1920x1440: 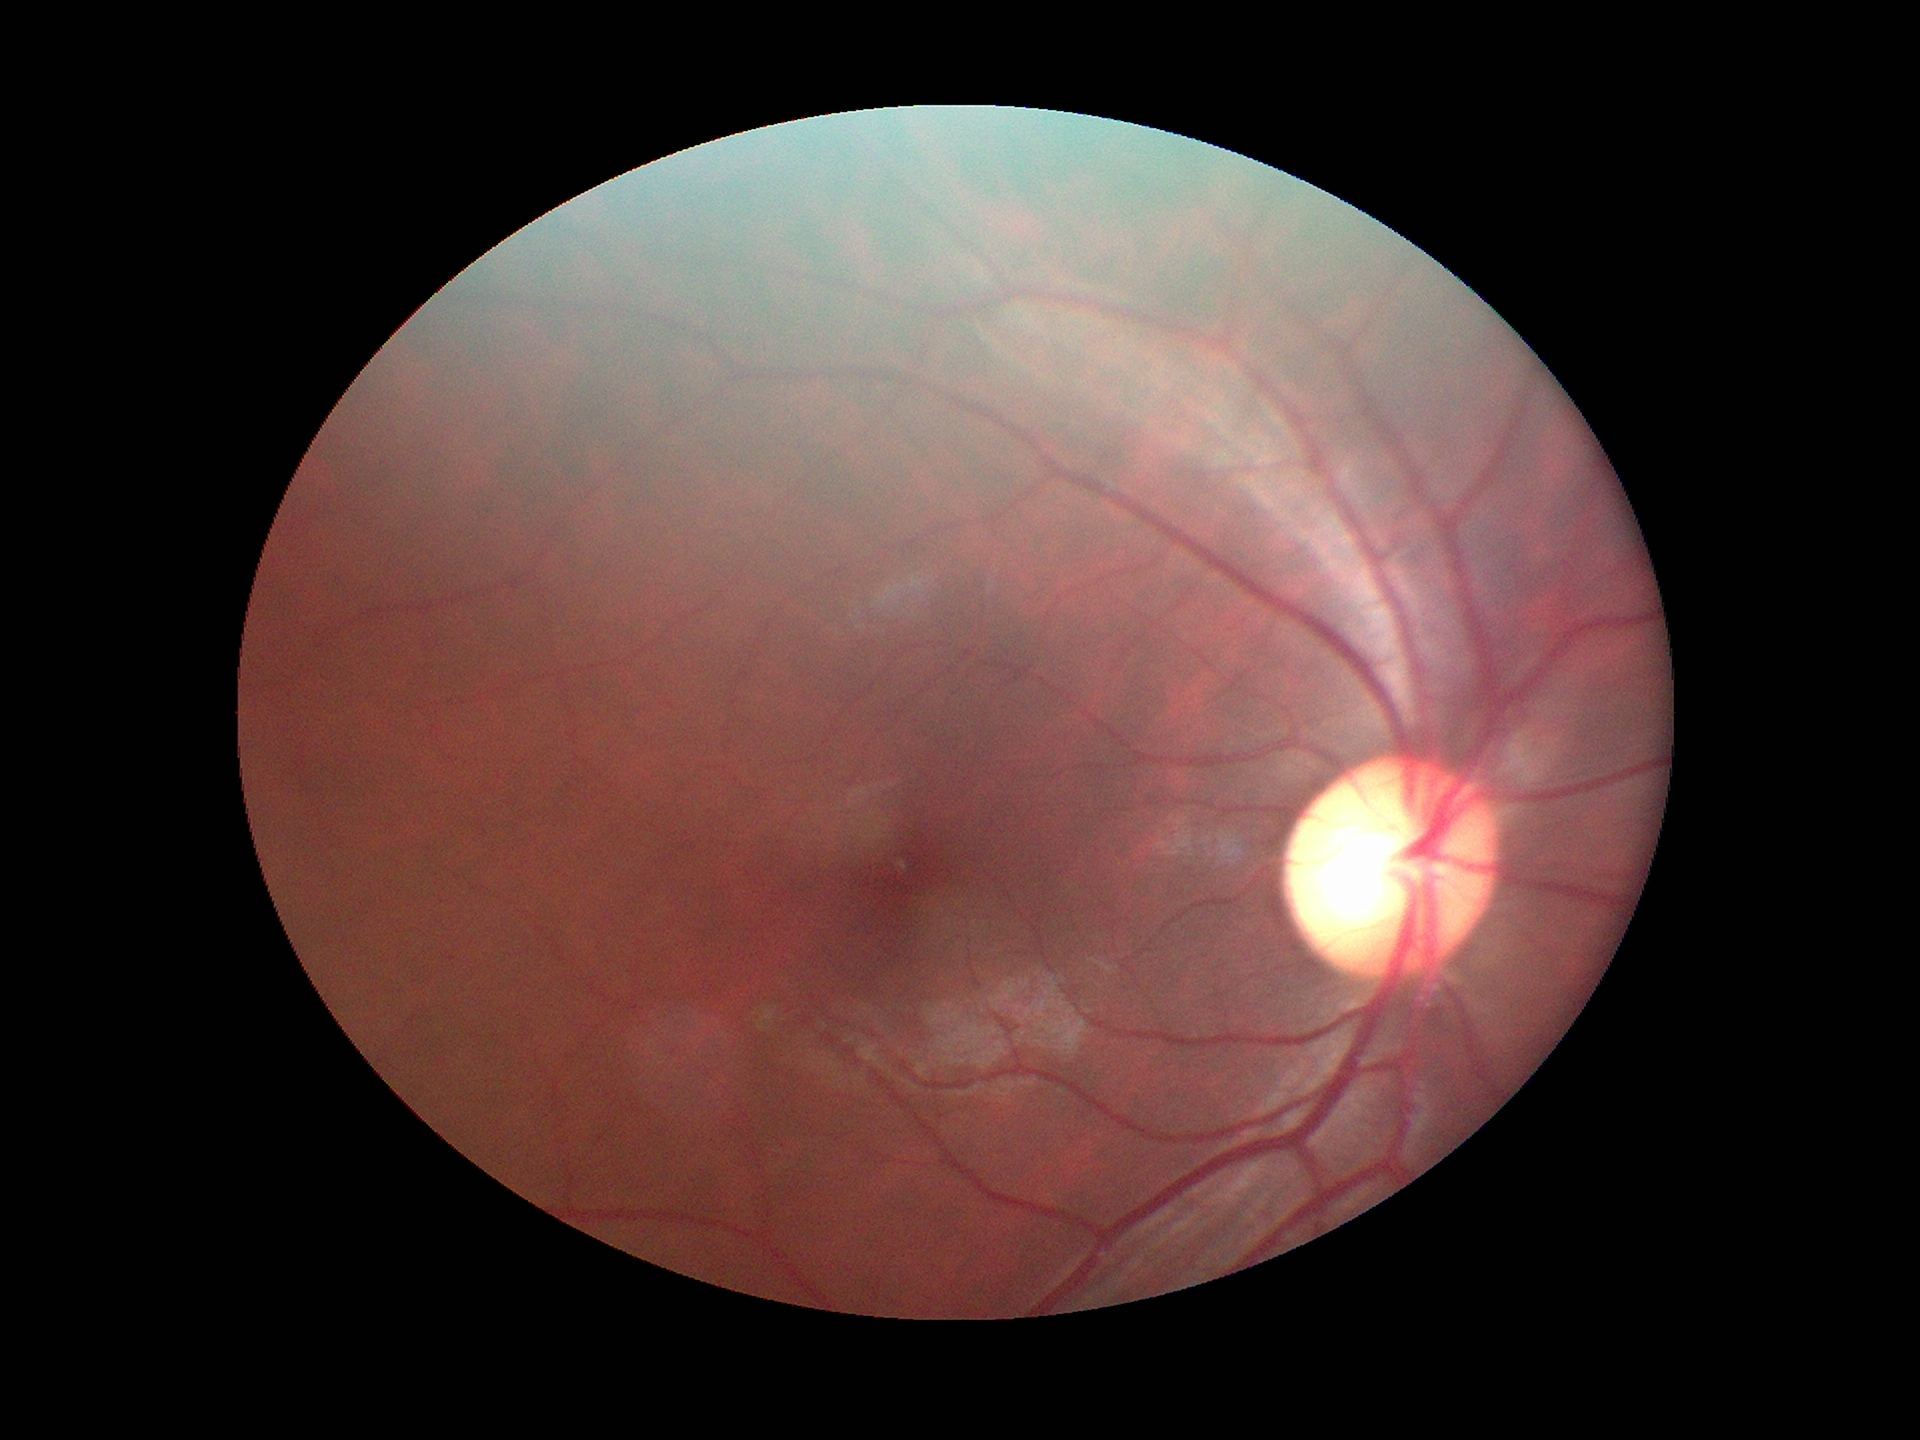 glaucoma_decision: suspicious findings
acdr: 0.31
vcdr: 0.58
hcdr: 0.56